Image size 848x848 · 45-degree field of view · retinal fundus photograph · without pupil dilation.
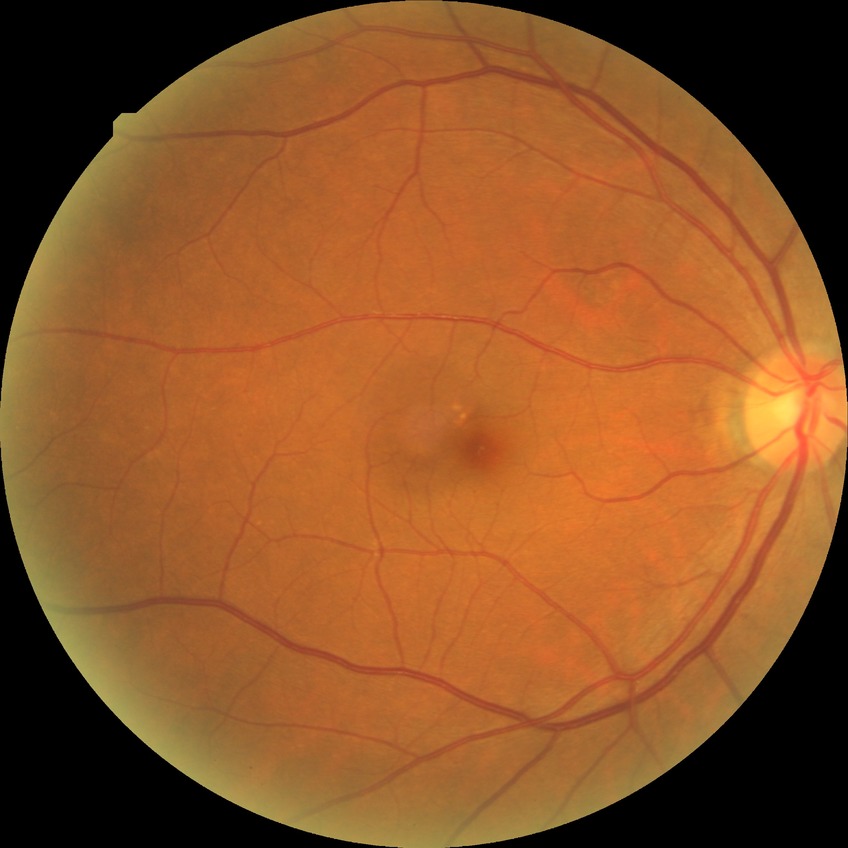

diabetic retinopathy stage=no diabetic retinopathy.